FOV: 45 degrees, 2212 x 1659 pixels, fundus photo.
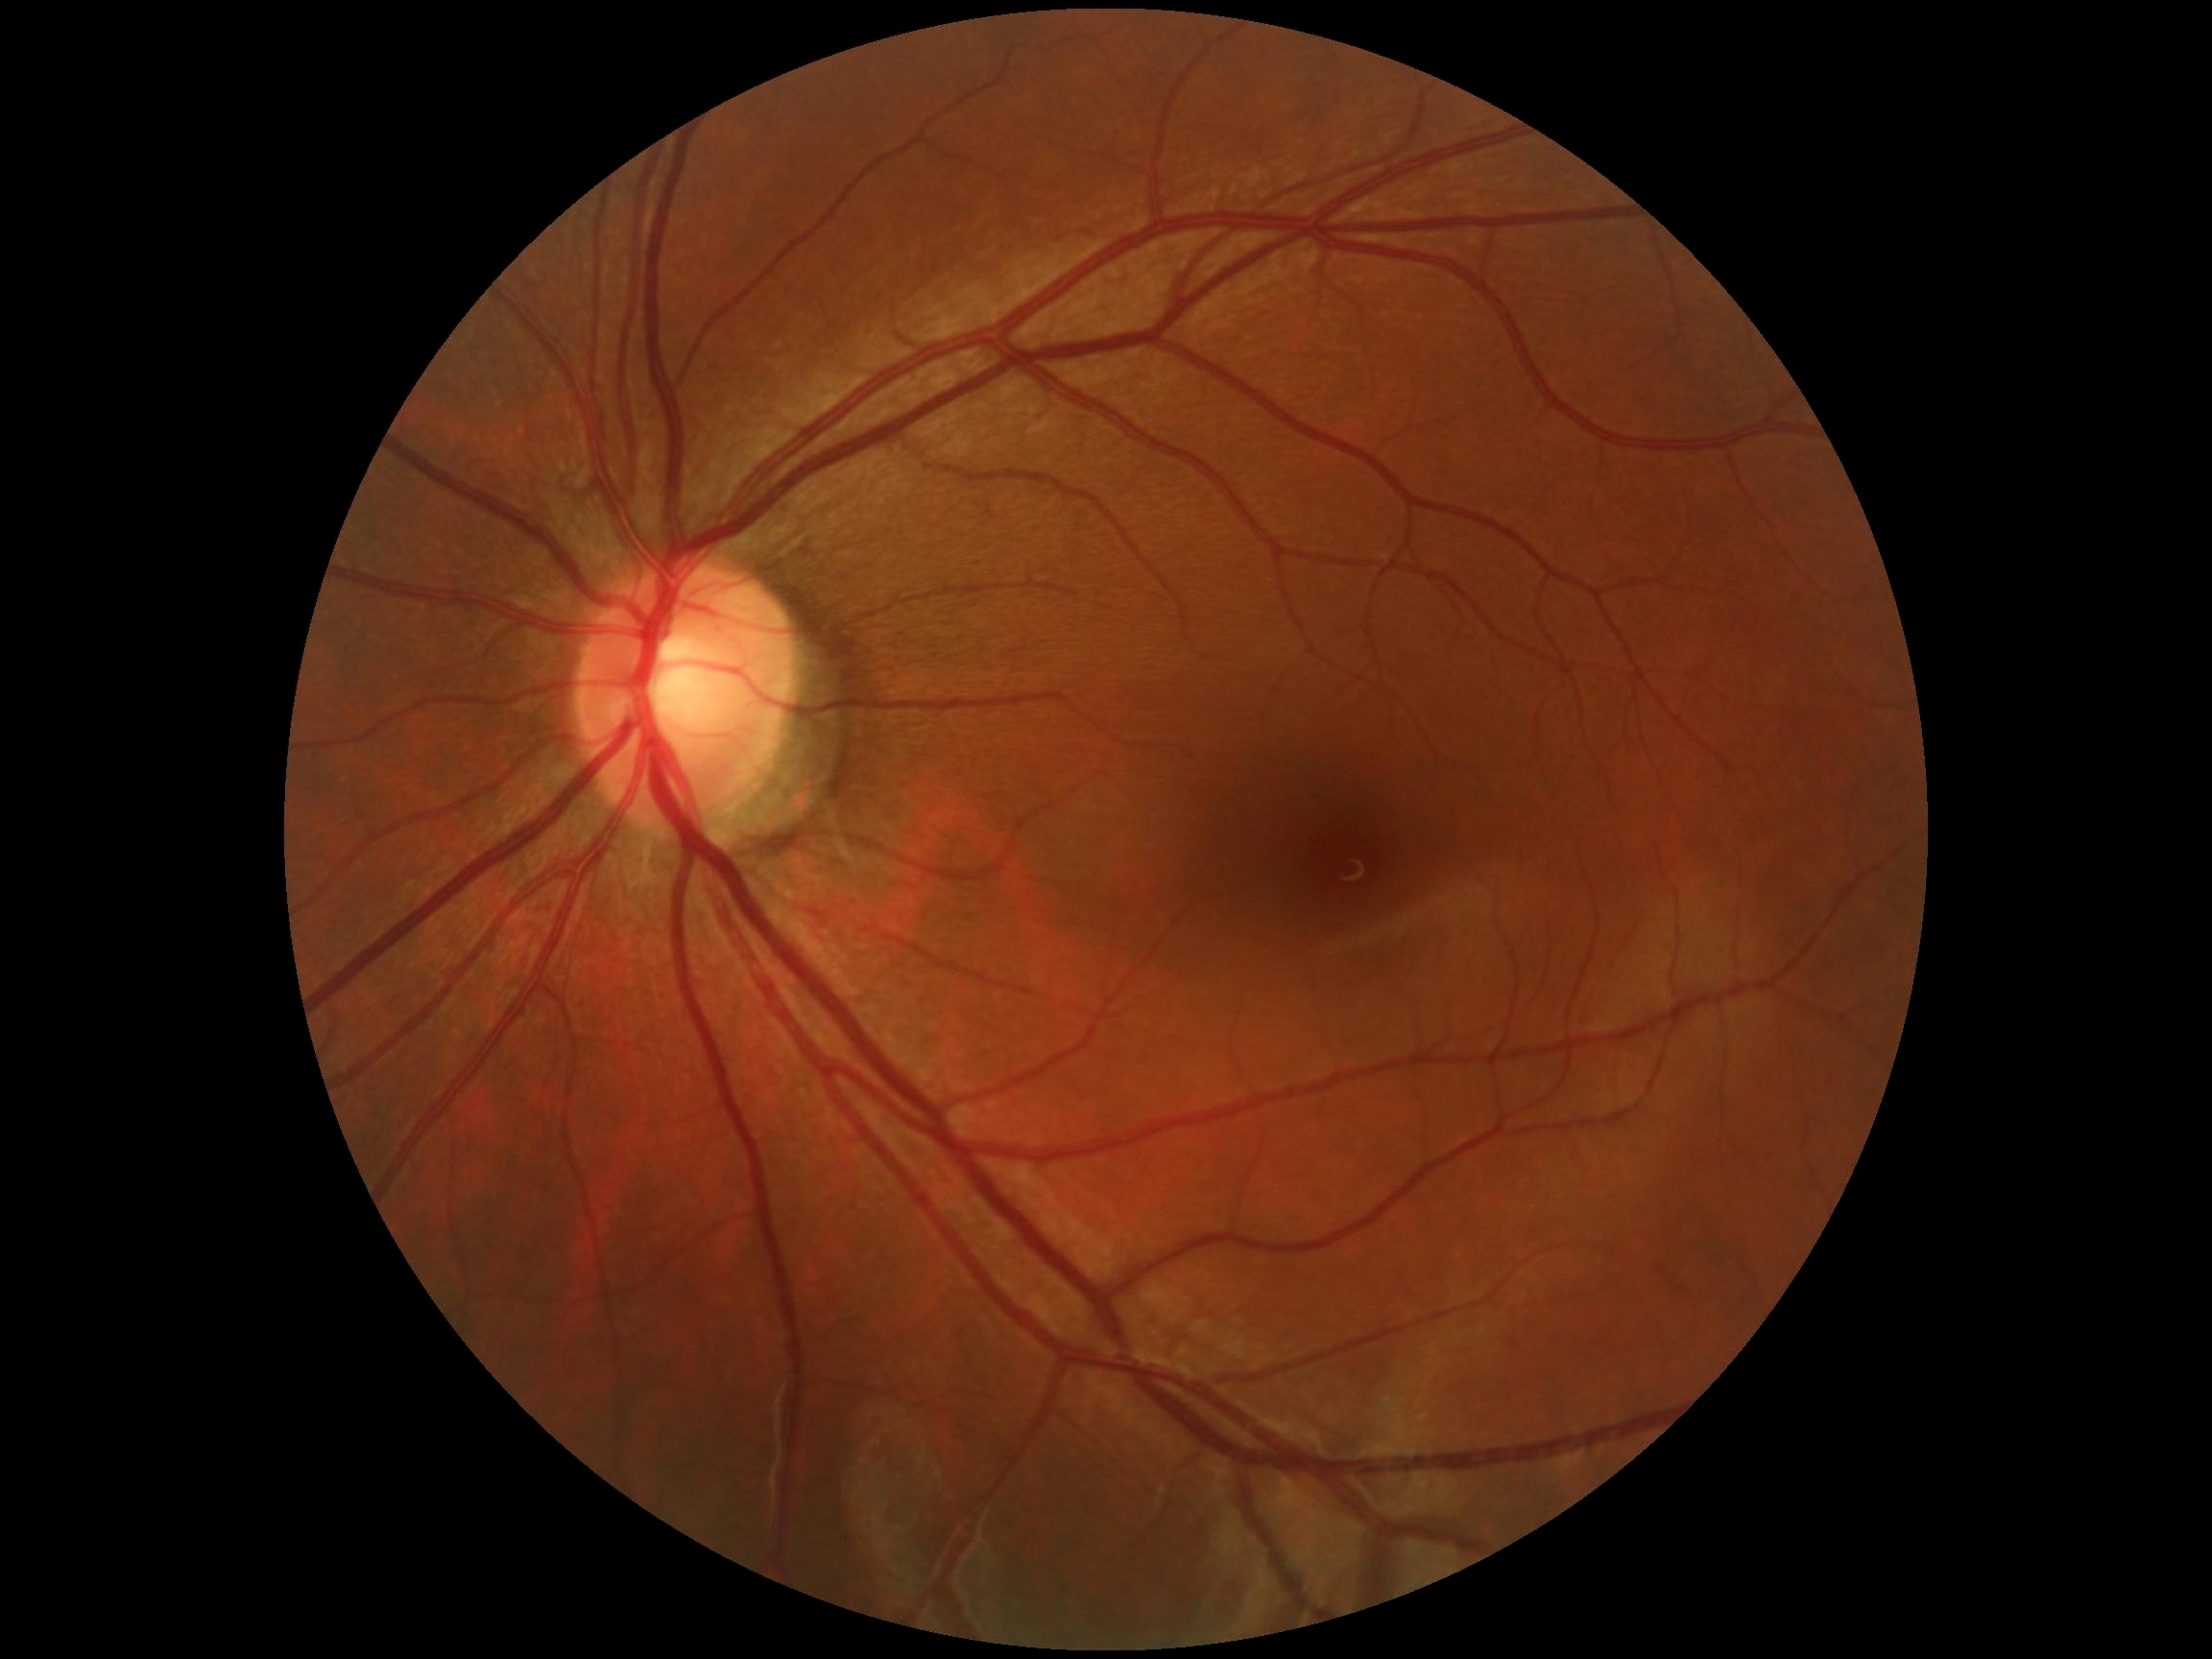
diabetic retinopathy grade=0.